Image size 2346x1568: 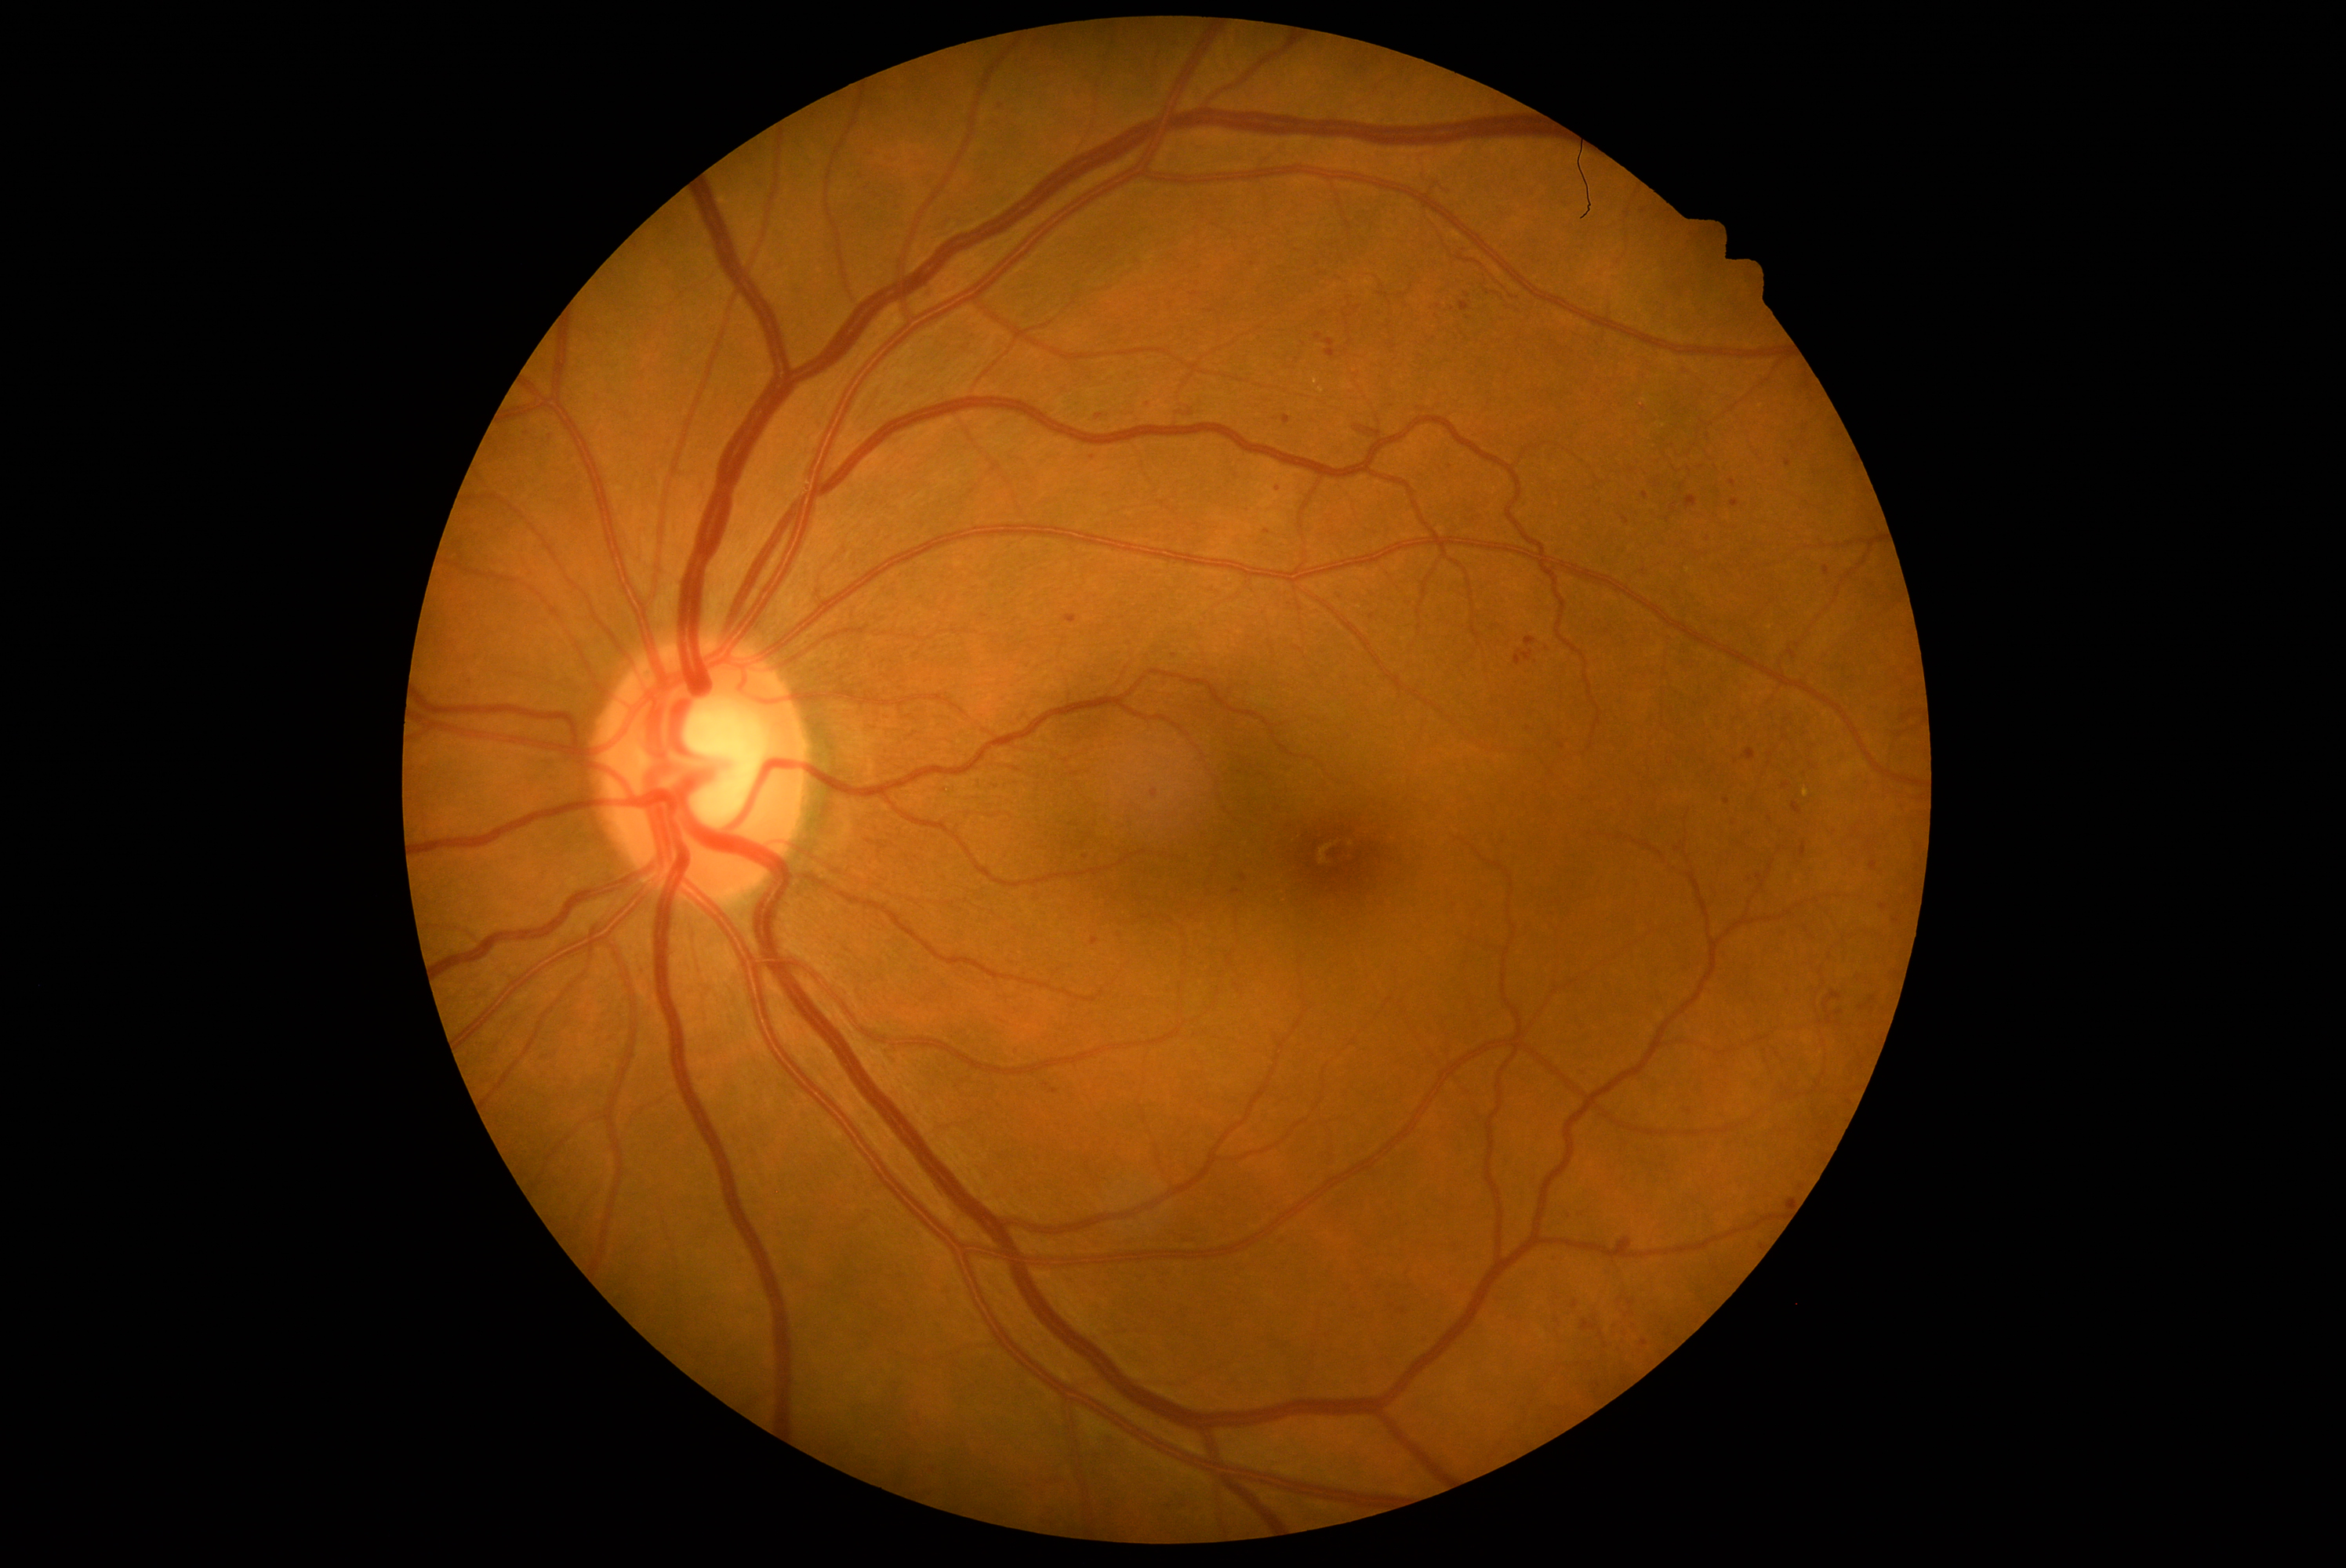 Diabetic retinopathy severity: grade 2 (moderate NPDR).
Microaneurysms are present, including at <region>543, 432, 557, 446</region>; <region>1428, 303, 1434, 311</region>; <region>1064, 615, 1077, 625</region>; <region>1730, 499, 1740, 509</region>; <region>993, 101, 1004, 114</region>; <region>1621, 1338, 1630, 1346</region>; <region>1799, 843, 1807, 858</region>; <region>1782, 782, 1790, 789</region>; <region>1743, 749, 1756, 761</region>; <region>1040, 1503, 1058, 1519</region>; <region>1823, 990, 1843, 1025</region>; <region>1373, 1282, 1384, 1291</region>.
Additional small microaneurysms near x=1059, y=972; x=1093, y=458; x=1670, y=764; x=1468, y=319; x=1562, y=747; x=1727, y=802; x=1770, y=818.